Fundus photo · modified Davis grading:
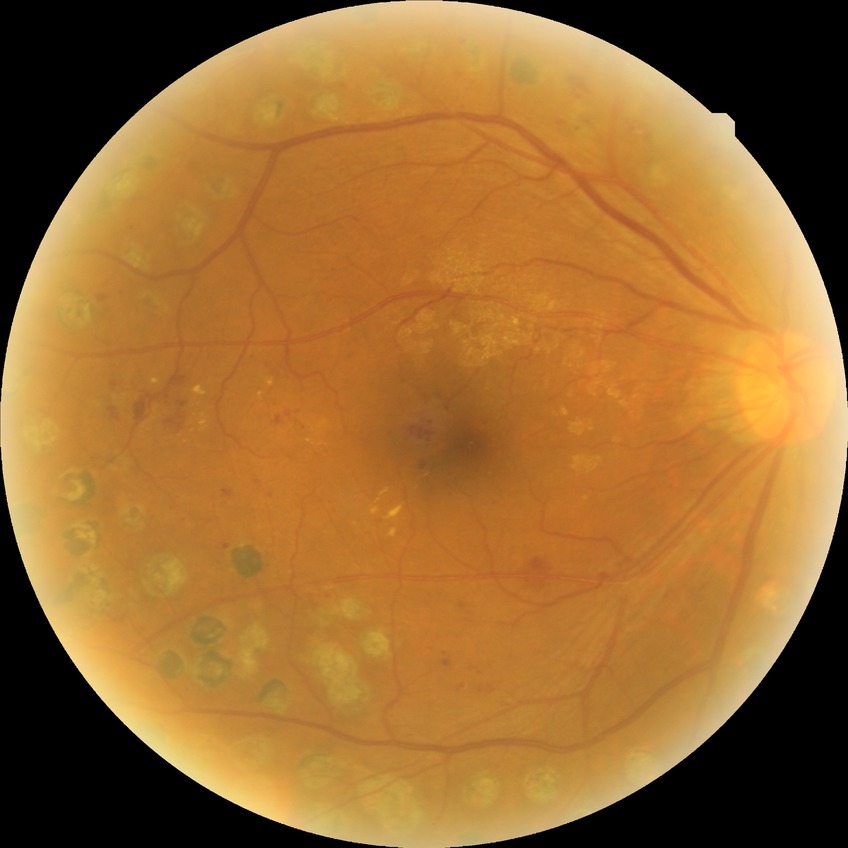 modified Davis grading: proliferative diabetic retinopathy.